Camera: Remidio Fundus on Phone — 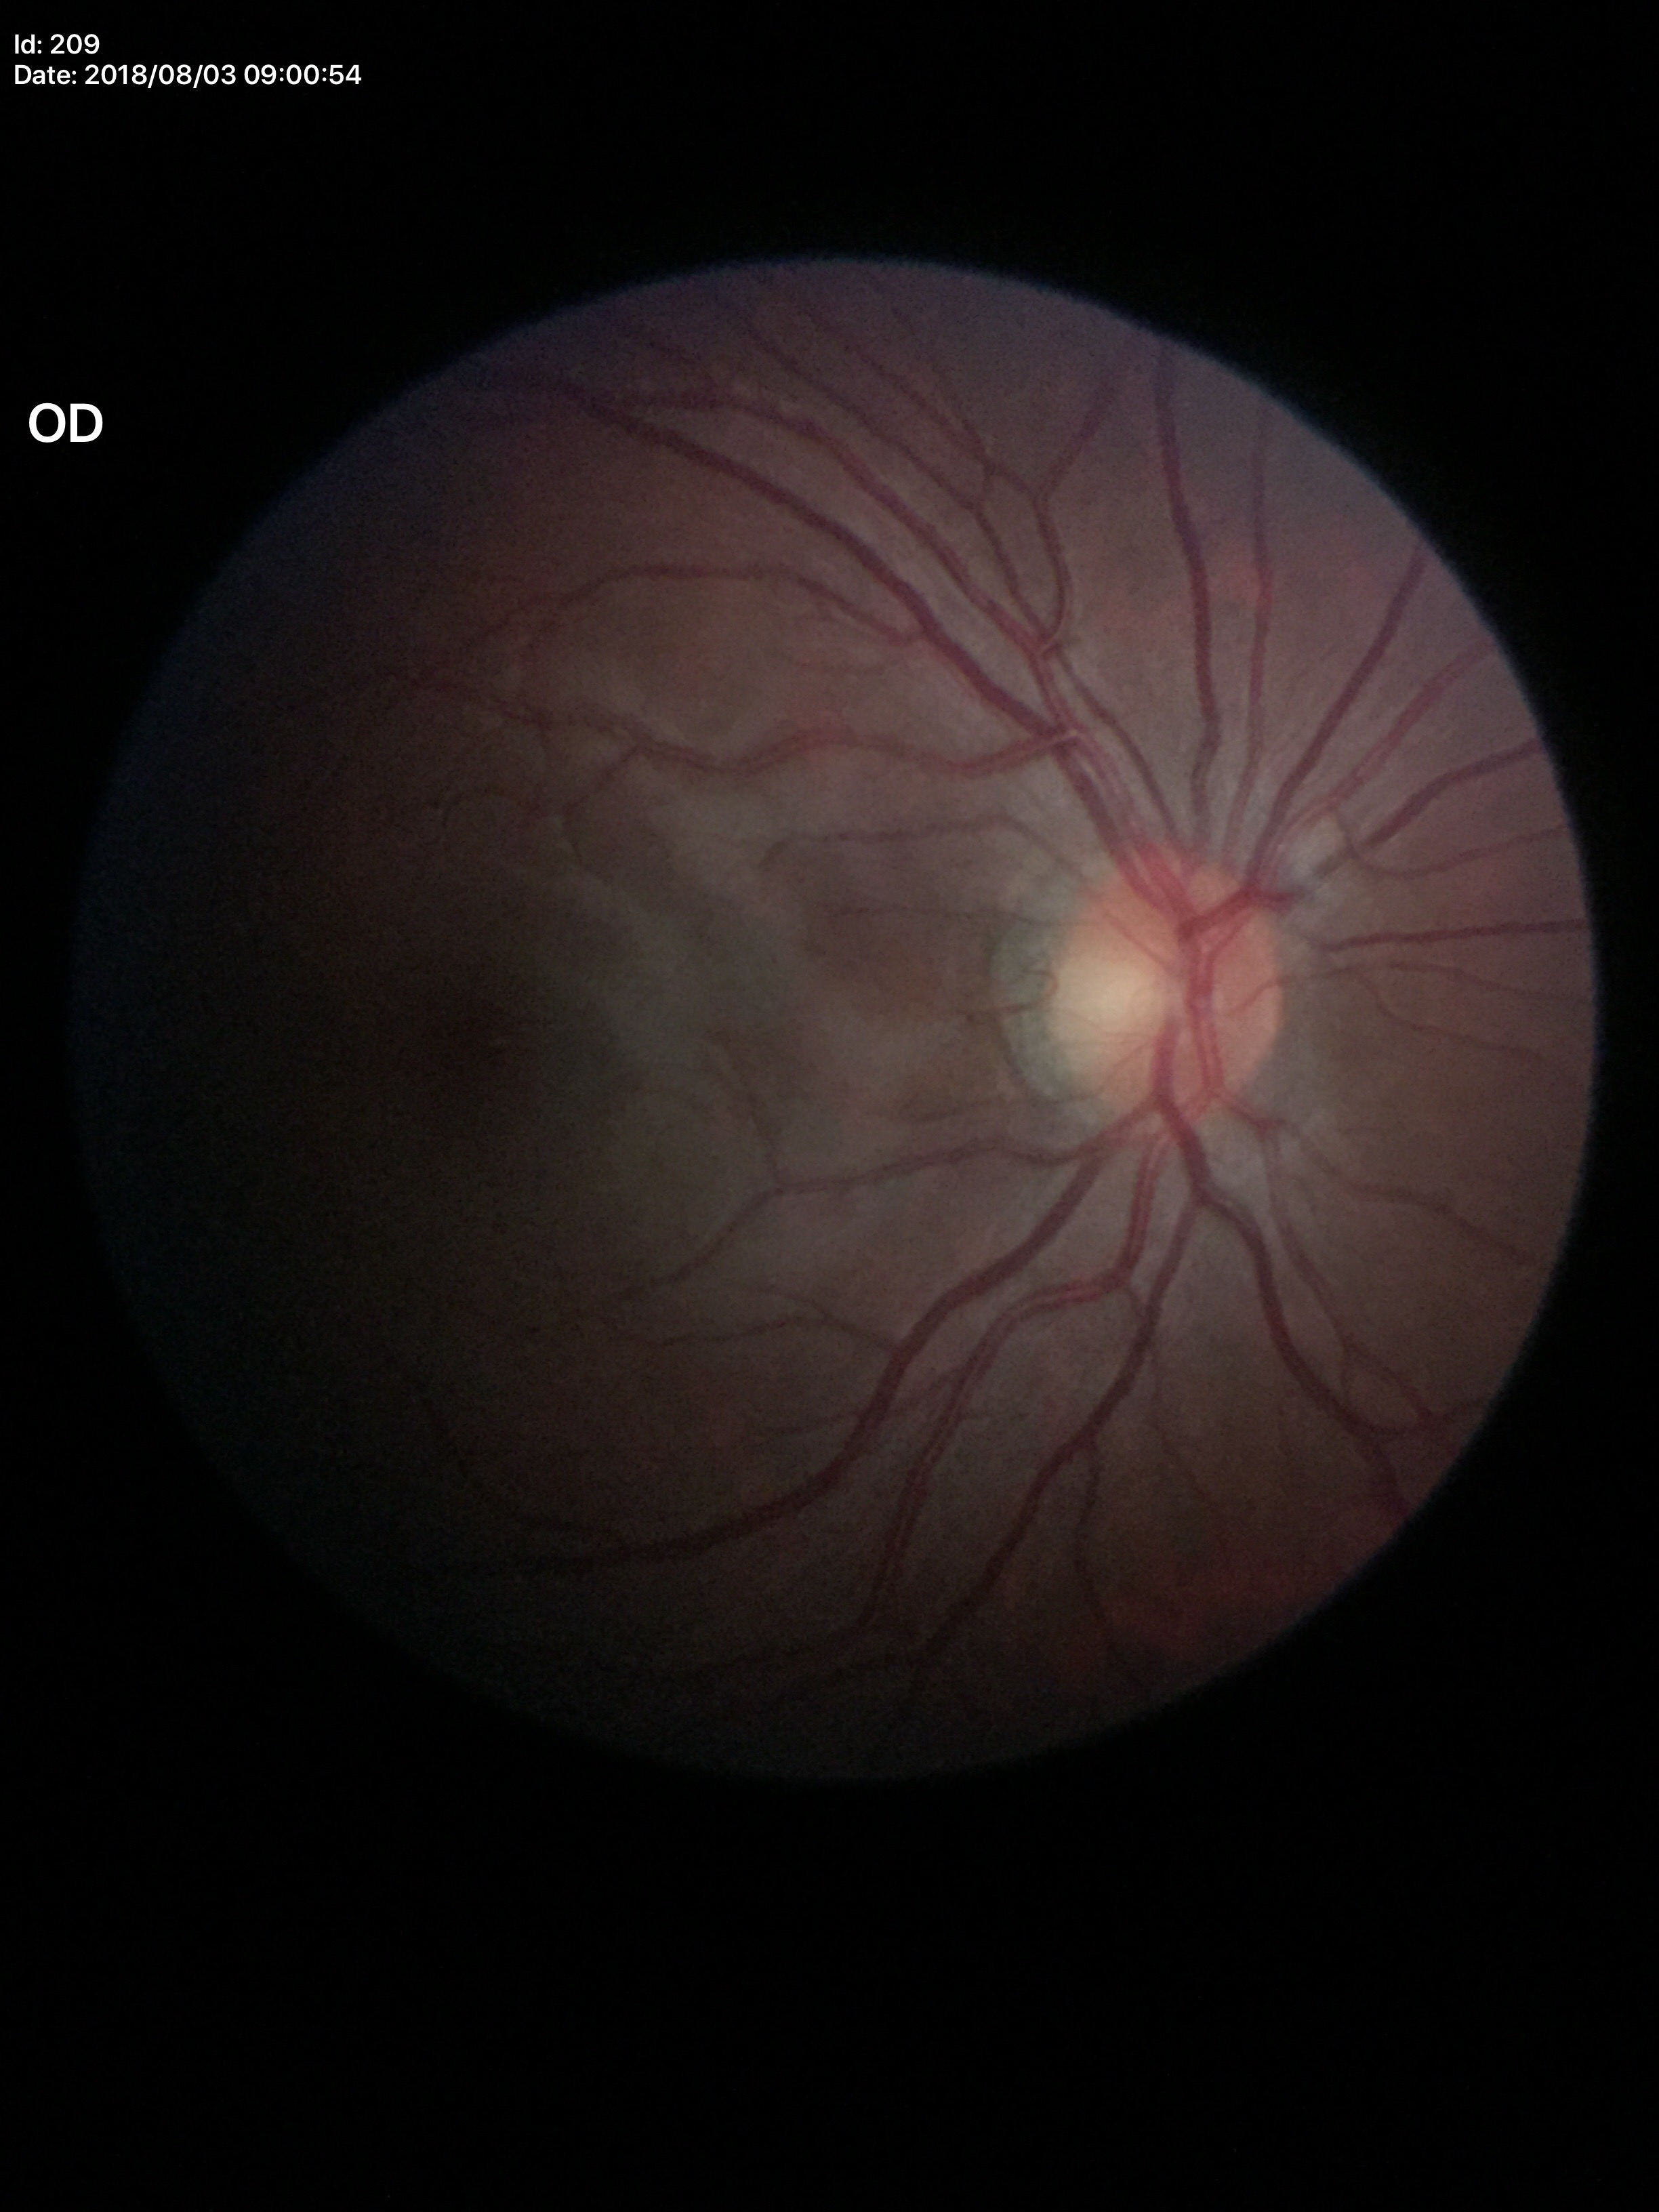 Optic disc analysis:
- HCDR · 0.47
- VCDR · 0.38
- Glaucoma evaluation · not suspect (unanimous normal call)